1534 by 1534 pixels, 50° FOV.
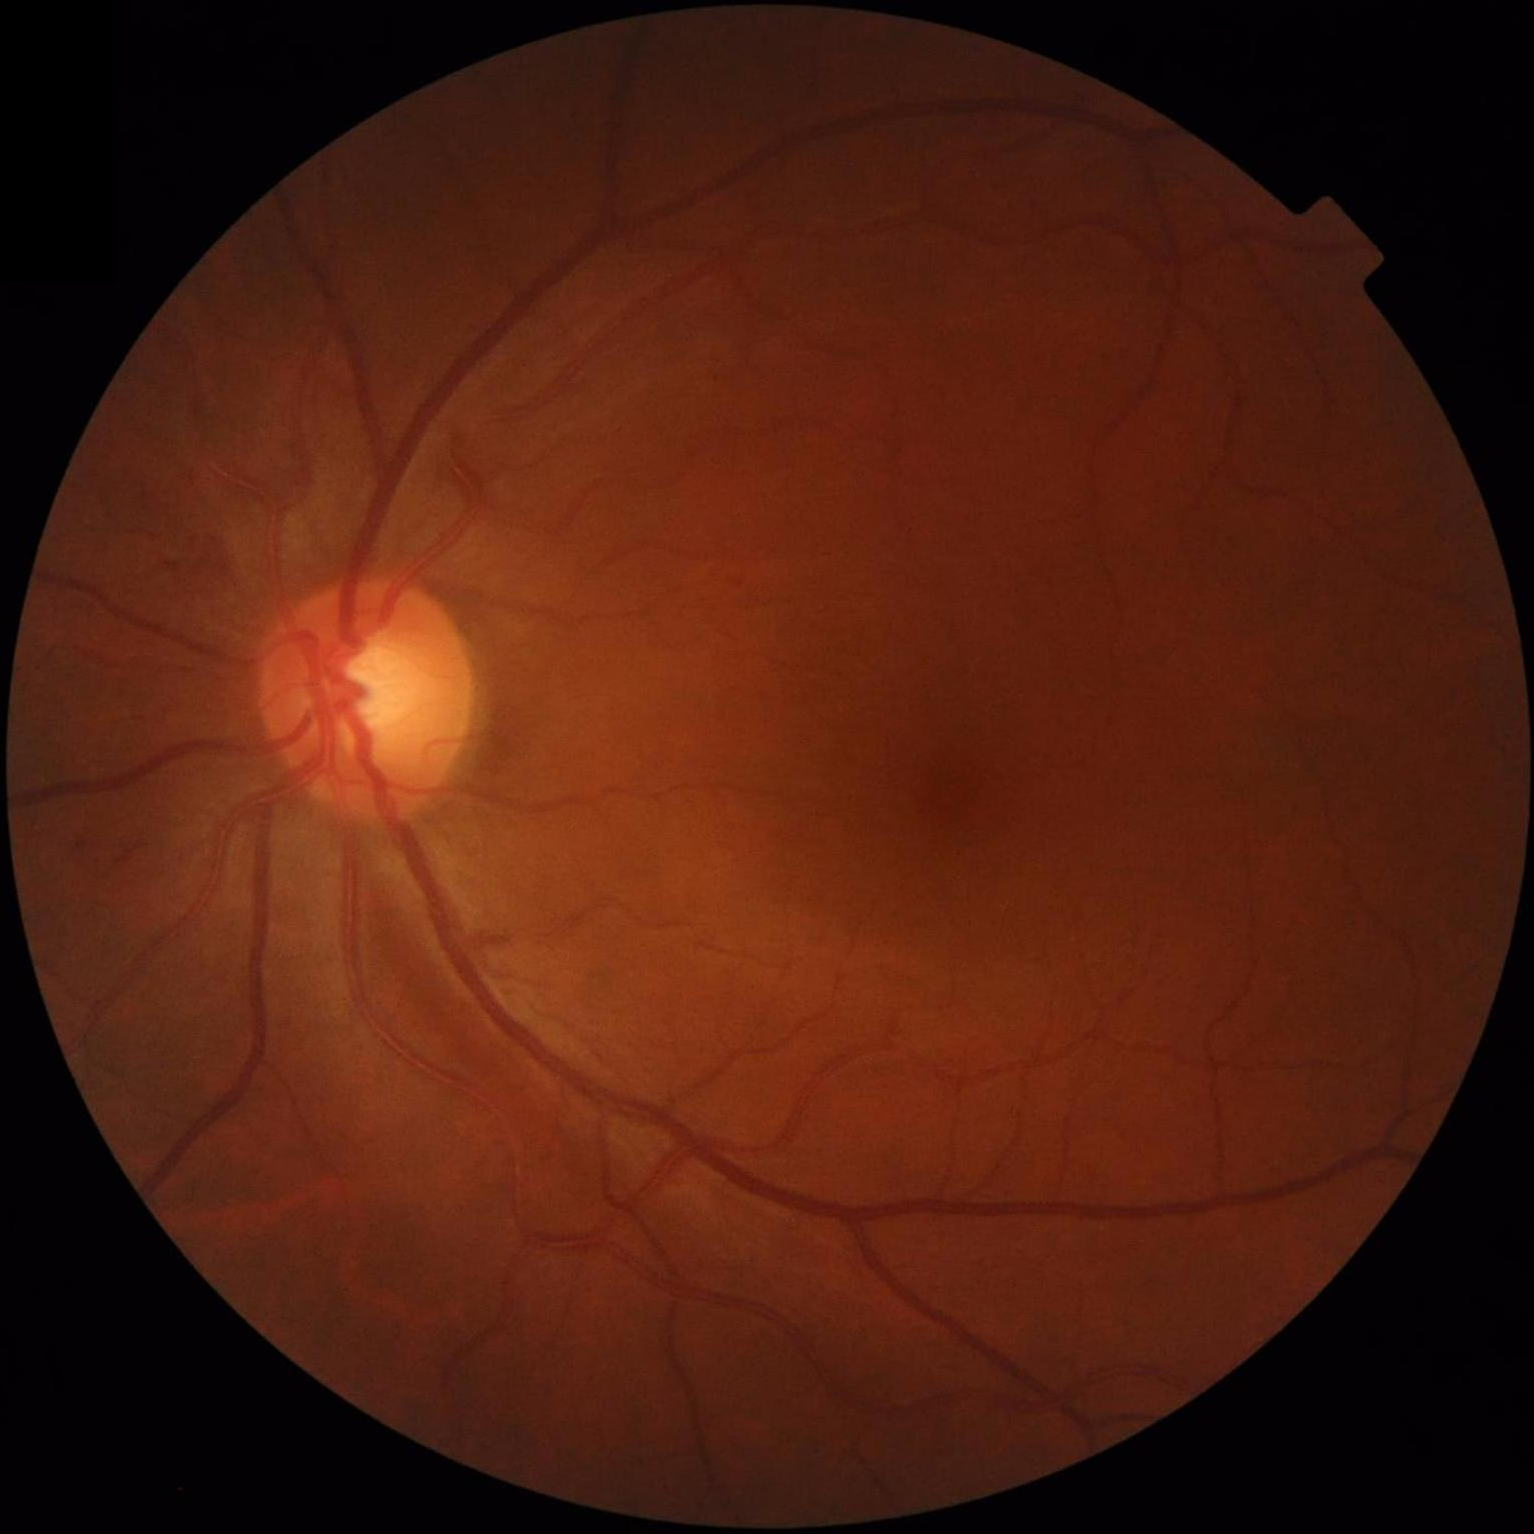

Clarity: in focus | Overall image quality: satisfactory | Contrast: adequate.